45° FOV:
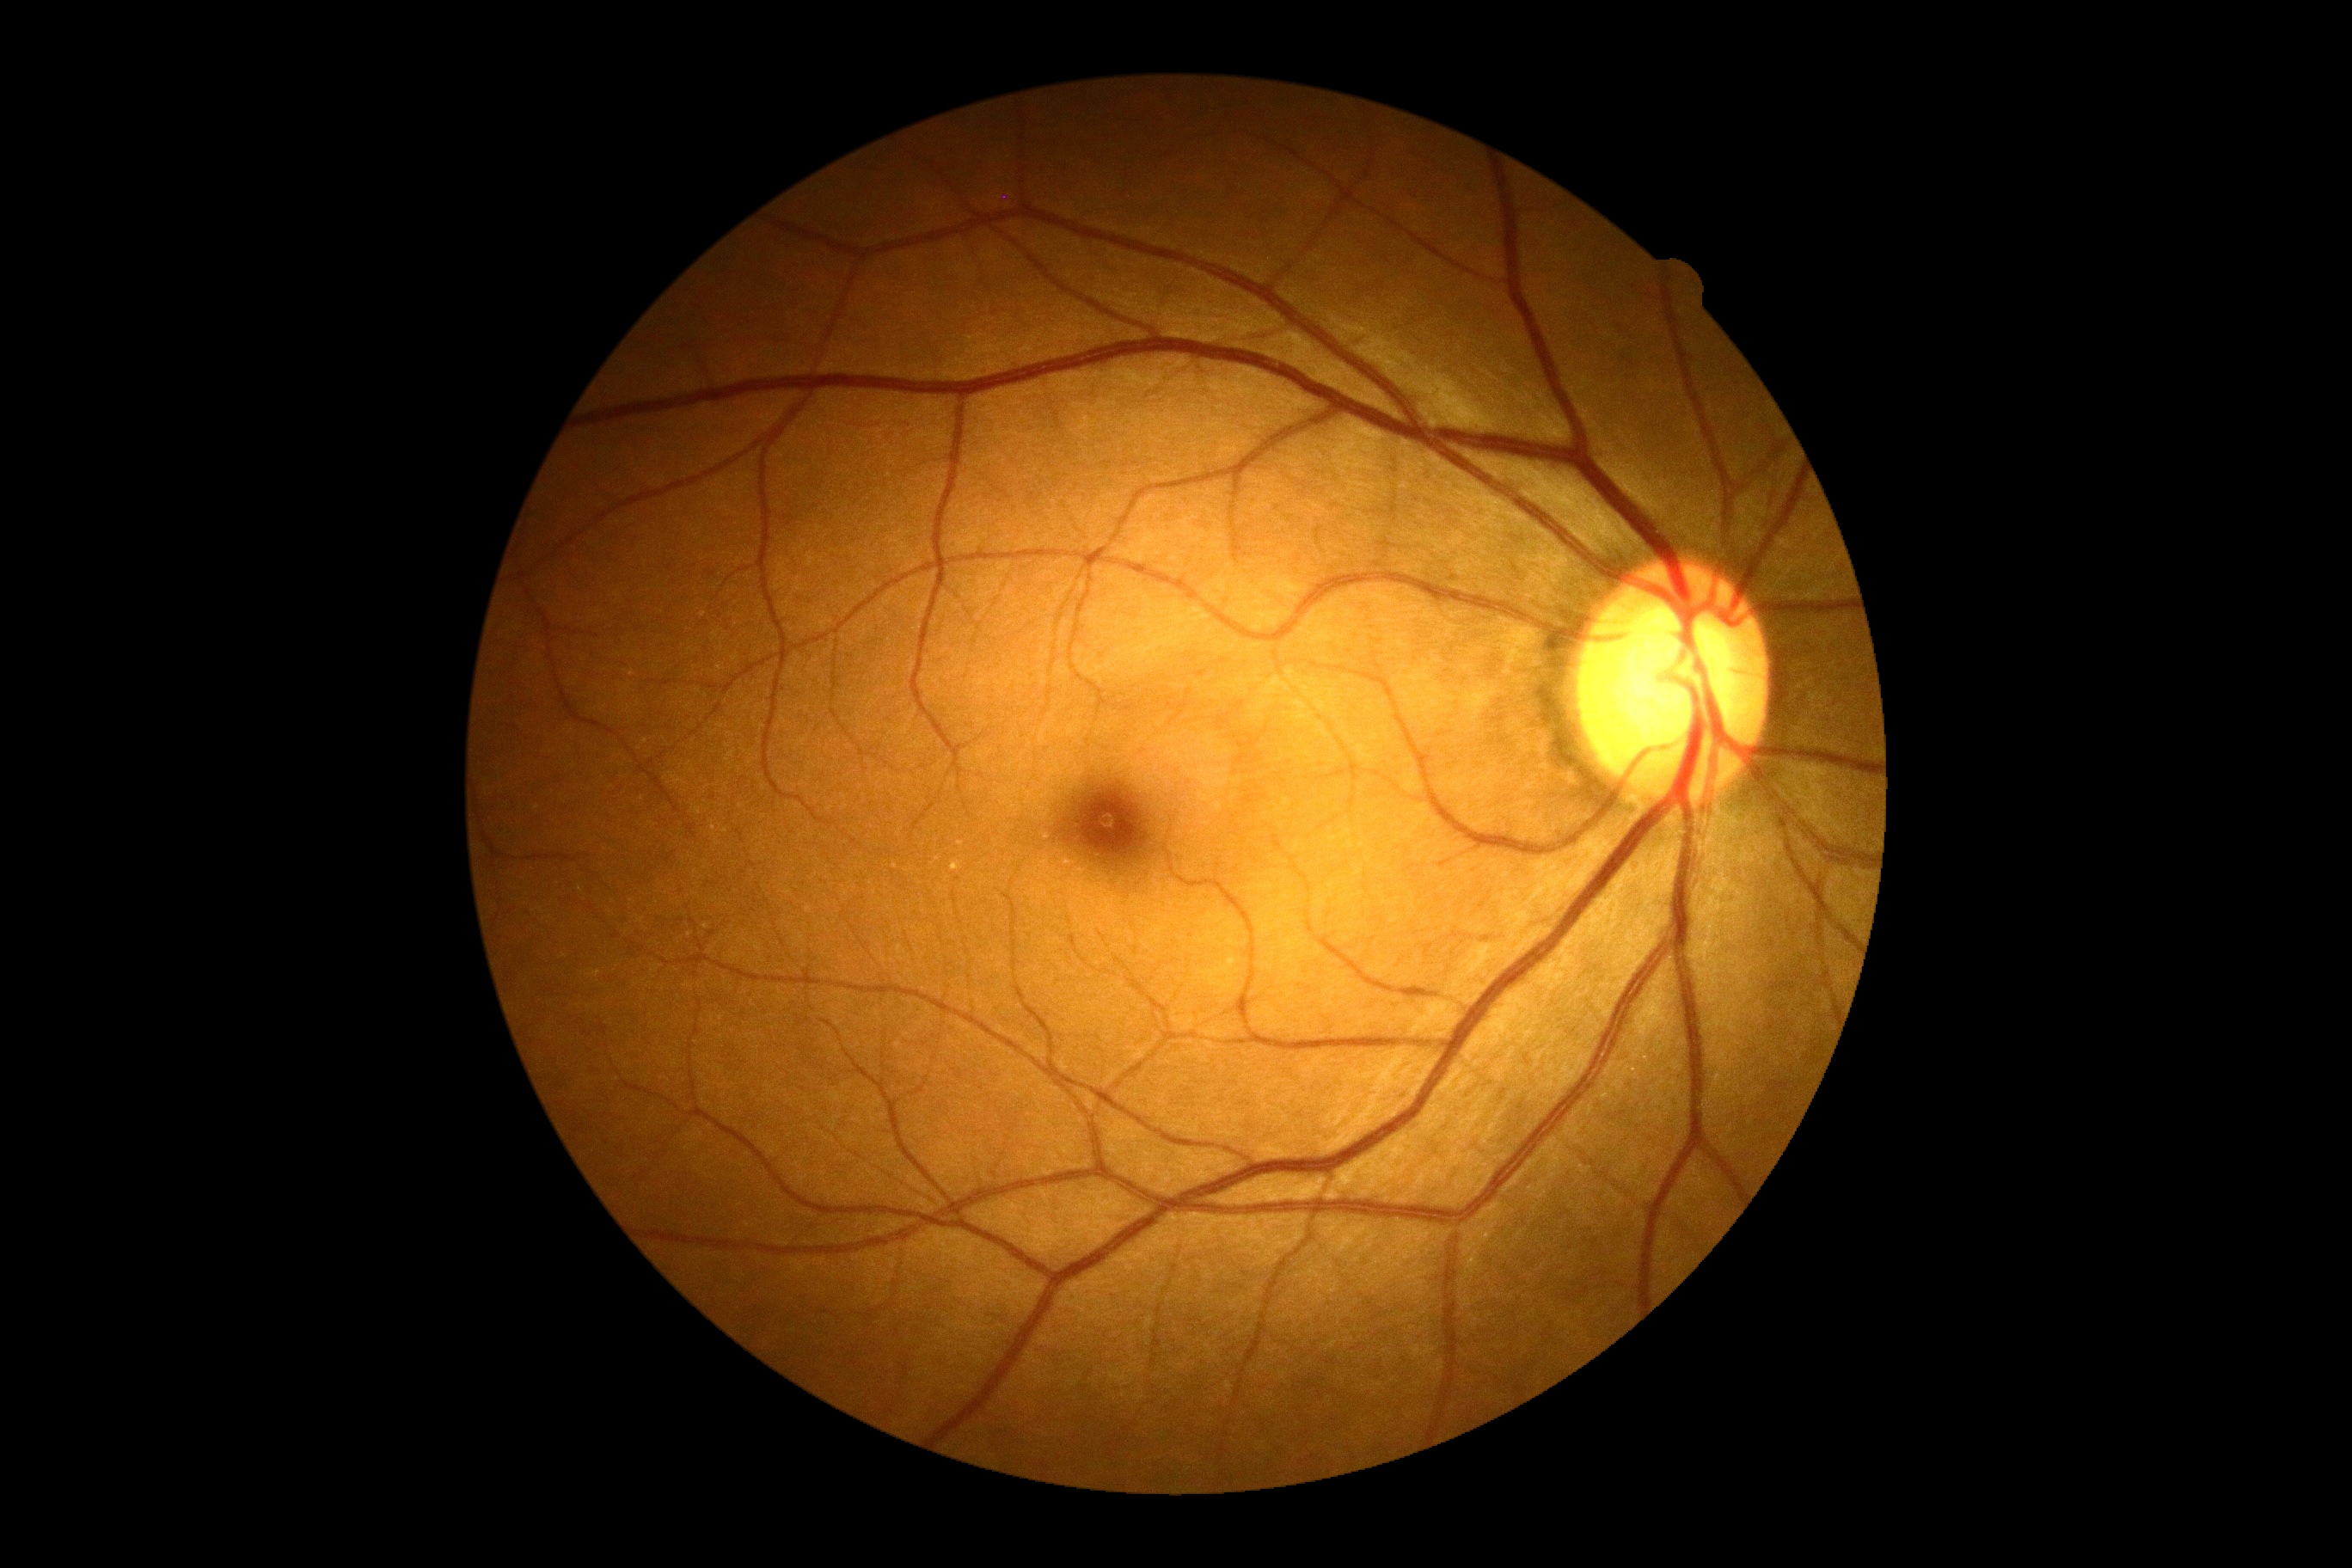 diabetic retinopathy (DR): grade 0 (no apparent retinopathy).